130° field of view (Clarity RetCam 3) · wide-field fundus photograph from neonatal ROP screening
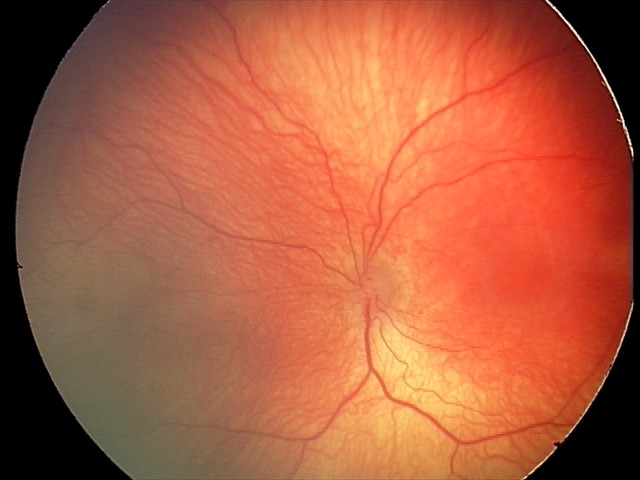
Assessment: retinopathy of prematurity (ROP) stage 2.